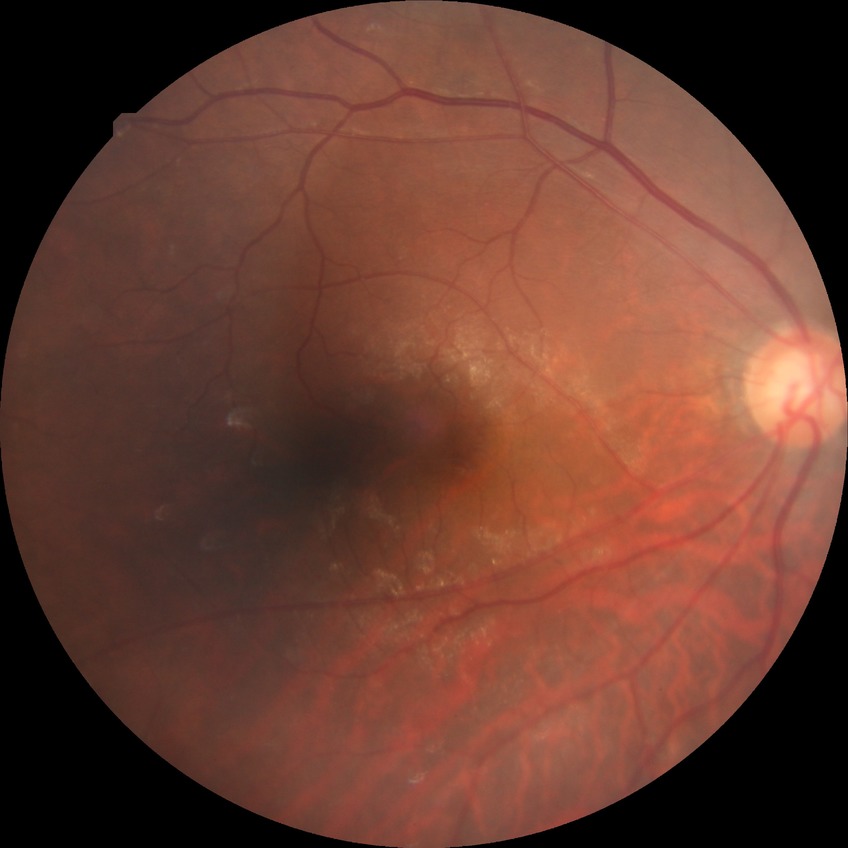
Diabetic retinopathy (DR) is simple diabetic retinopathy (SDR). DR class: non-proliferative diabetic retinopathy.